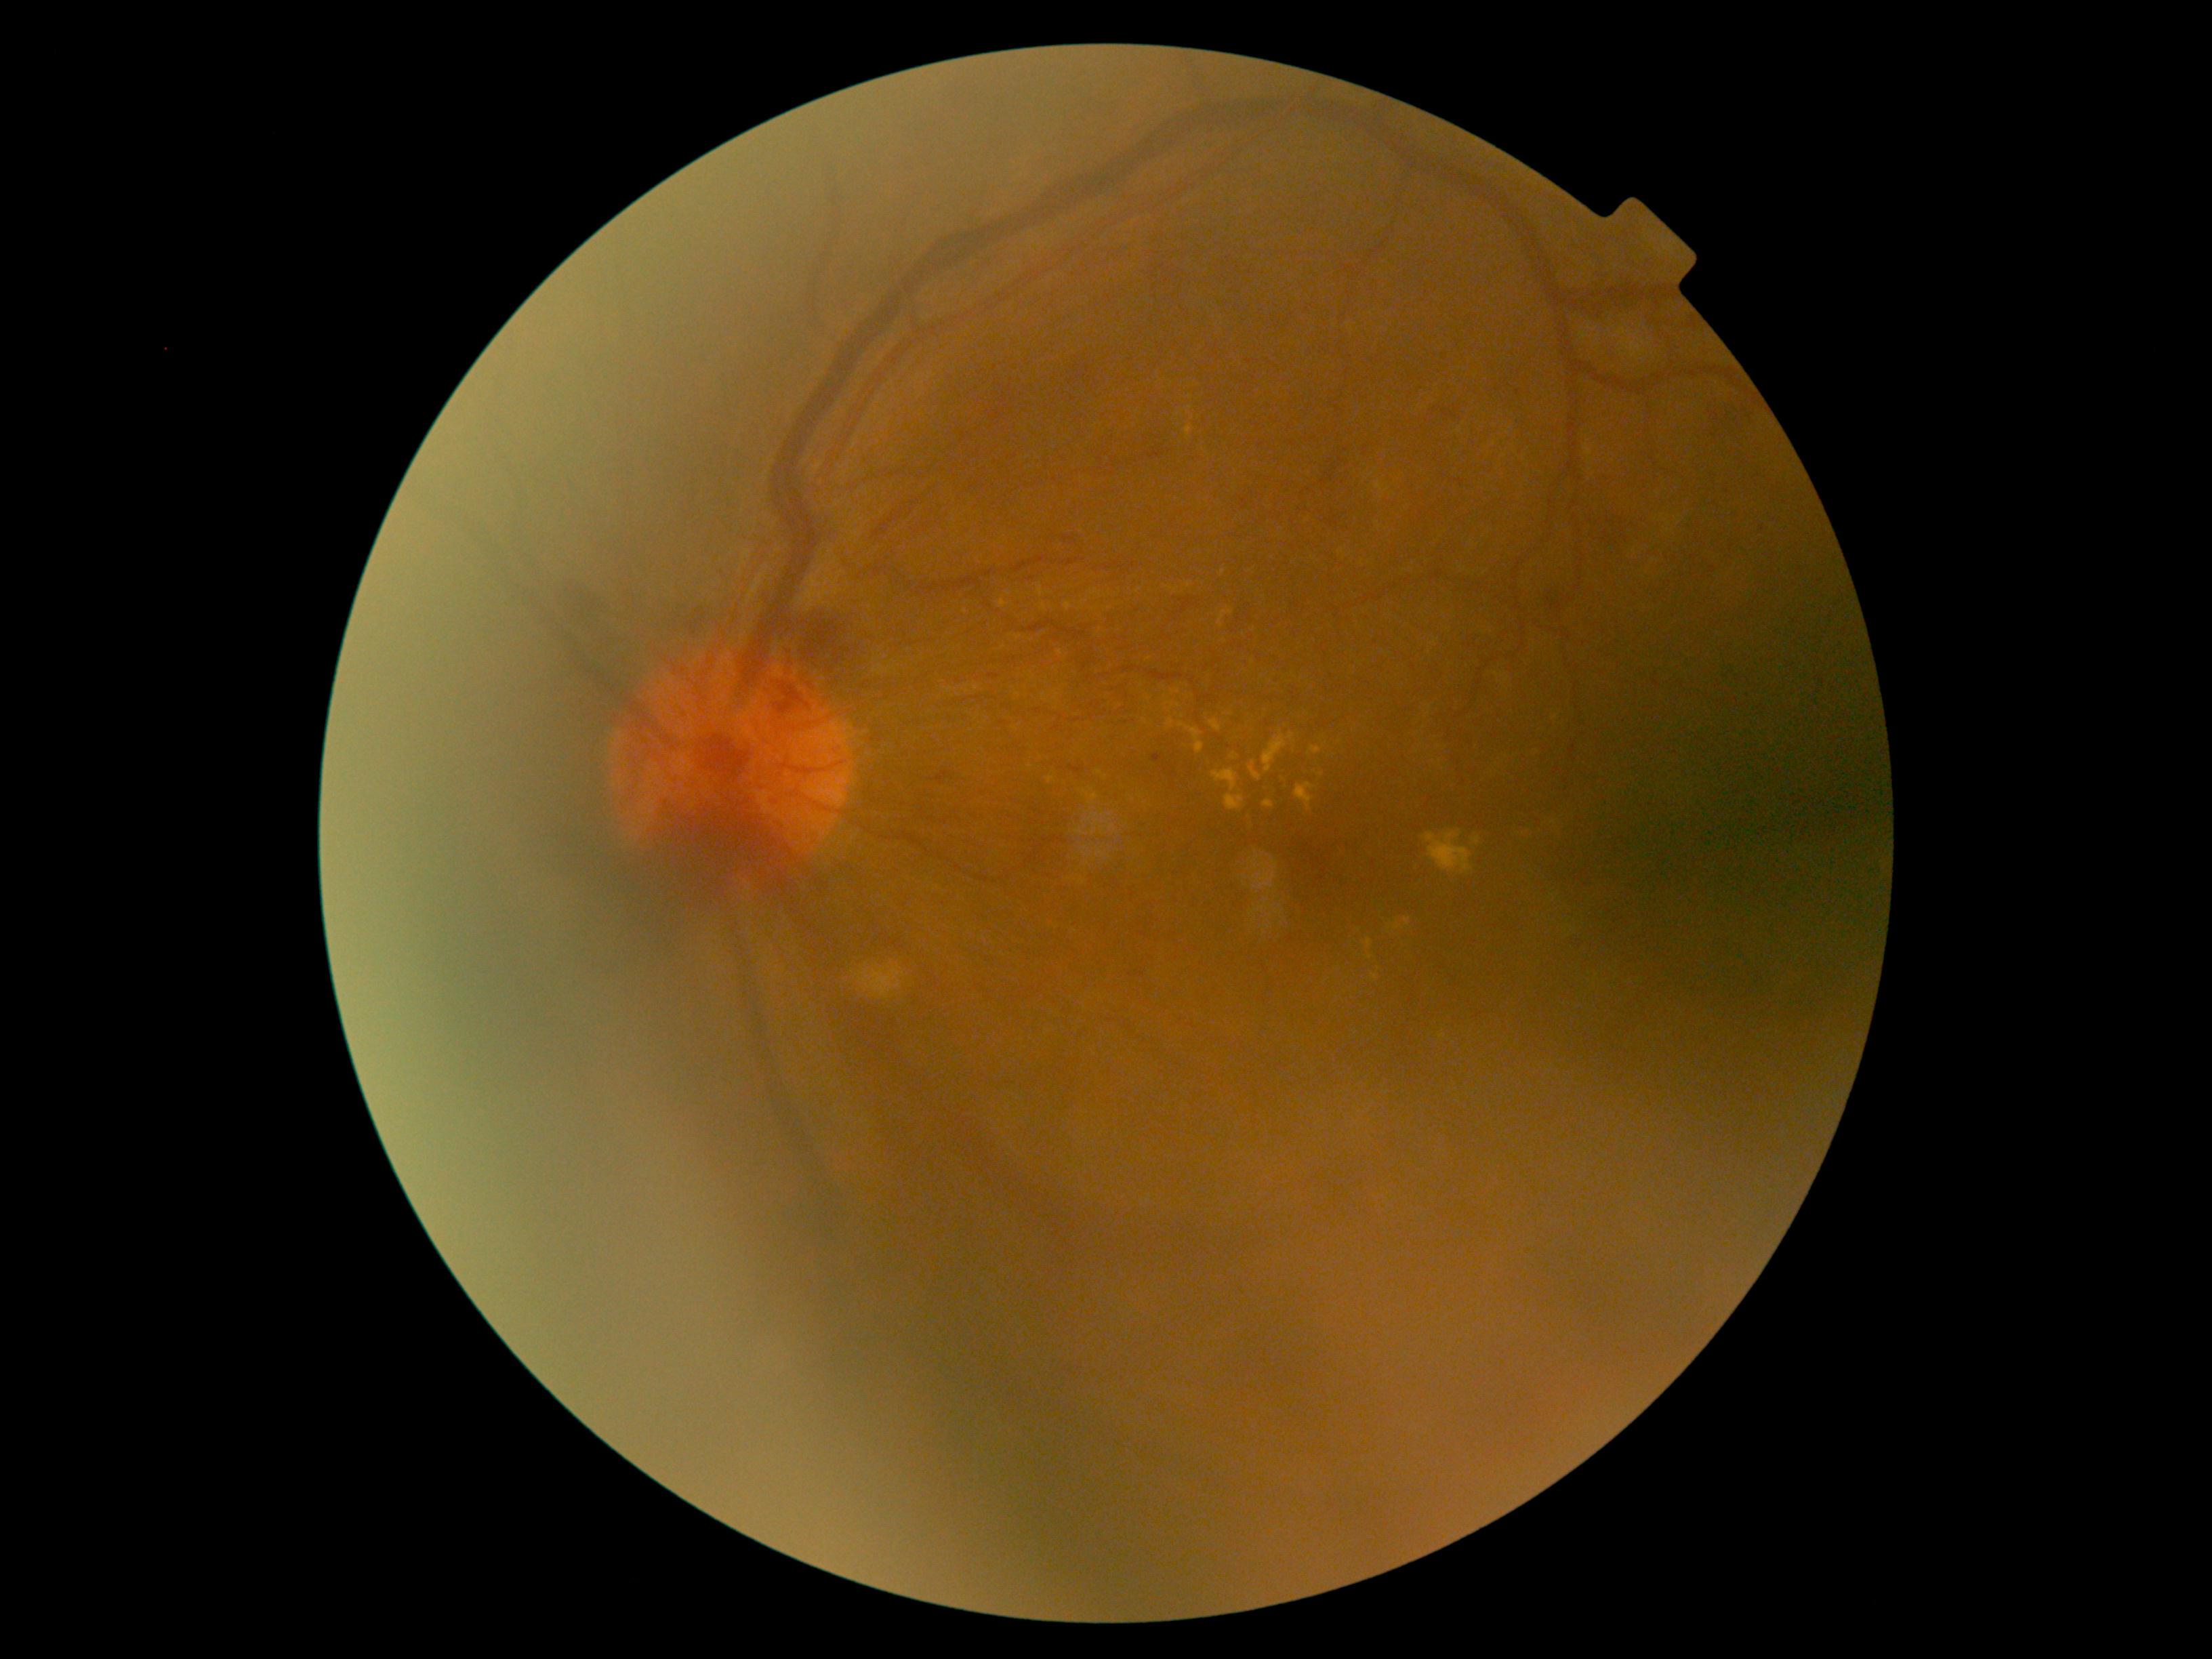
DR class: proliferative diabetic retinopathy. Diabetic retinopathy (DR): grade 4 — neovascularization and/or vitreous/pre-retinal hemorrhage.